2228x1652px. Captured after pupil dilation. CFP
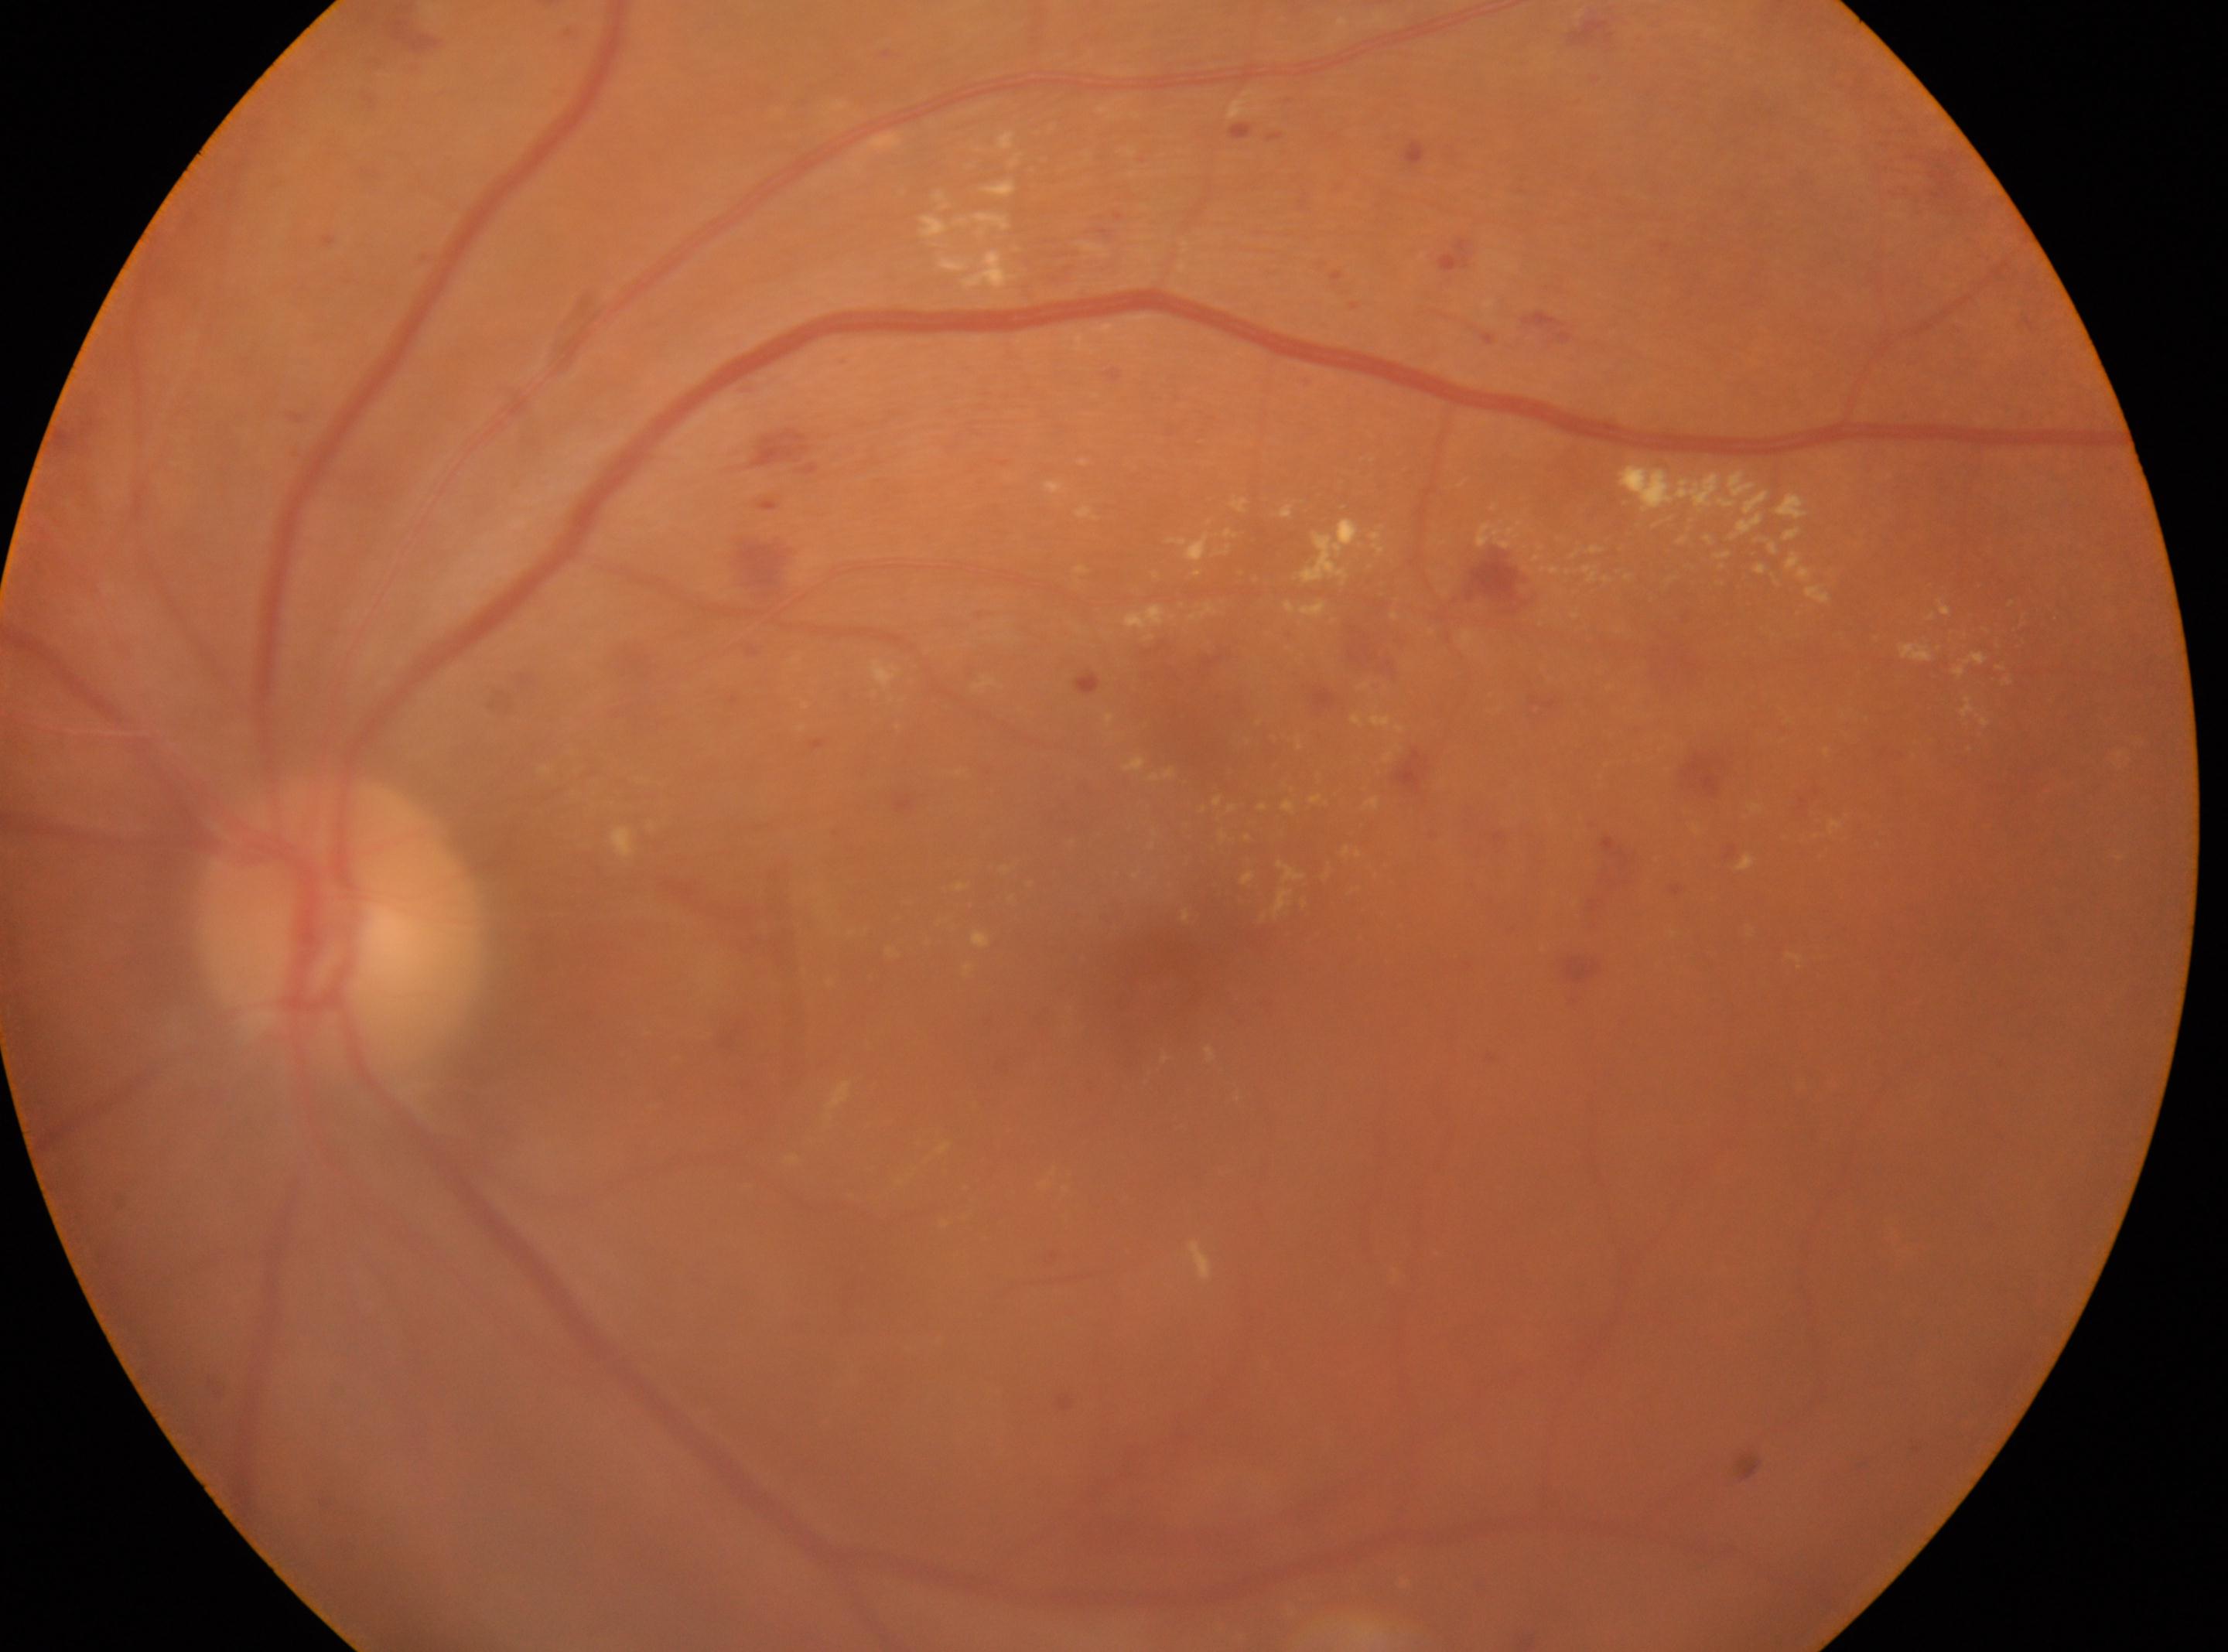

optic disc center: x=341, y=926 | DR severity: 2 | the left eye | fovea centralis: x=1159, y=987.